Pediatric wide-field fundus photograph; 1240 x 1240 pixels — 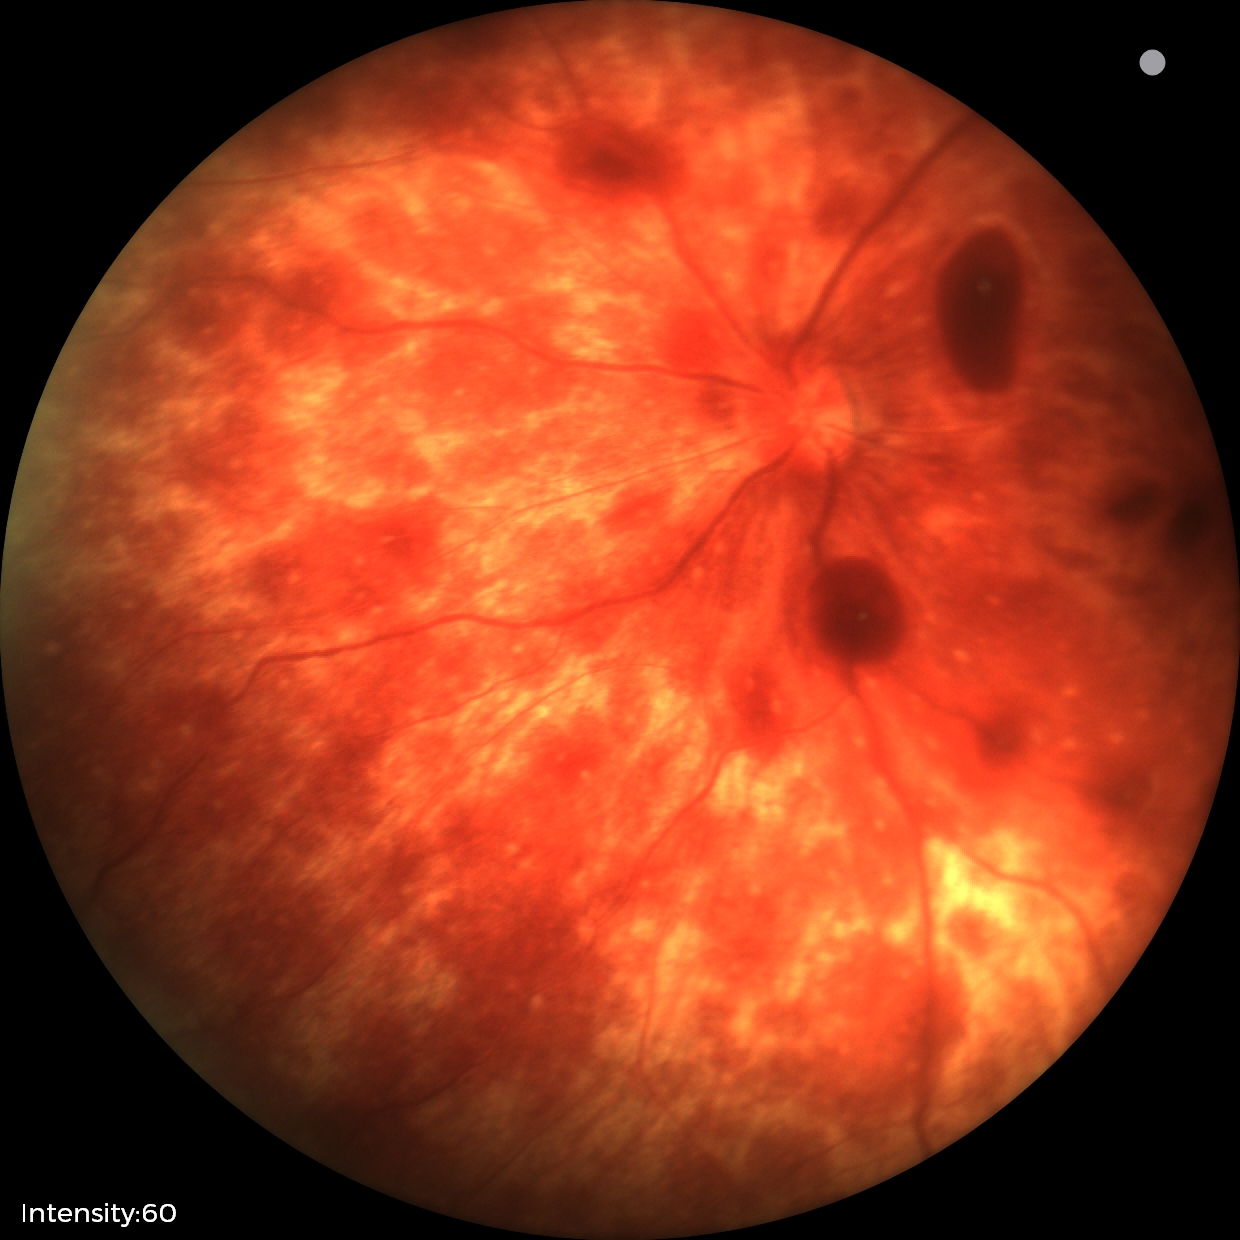

Screening series with retinal hemorrhages.